848x848px, nonmydriatic, 45° FOV, NIDEK AFC-230:
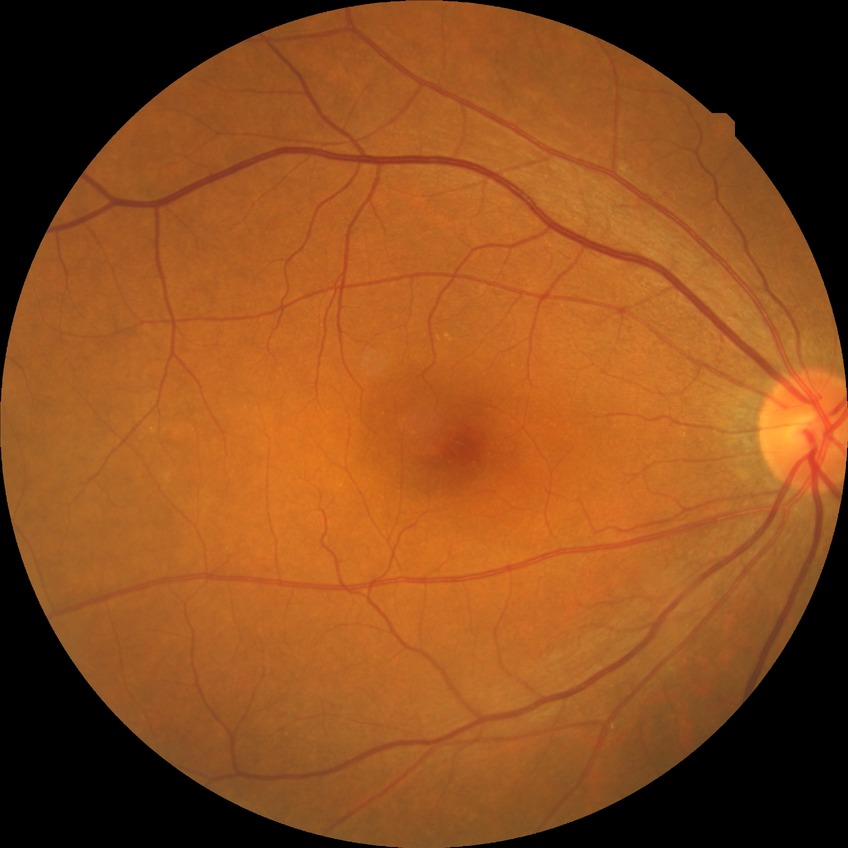
Annotations:
– diabetic retinopathy (DR): NDR (no diabetic retinopathy)